Clarity RetCam 3, 130° FOV; wide-field contact fundus photograph of an infant:
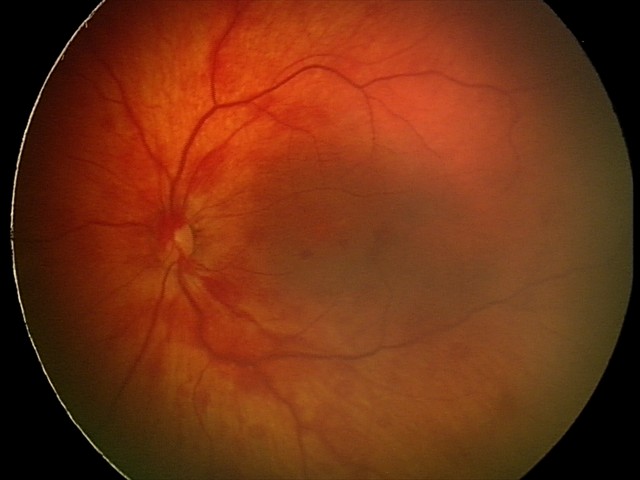
Screening diagnosis: retinal hemorrhages